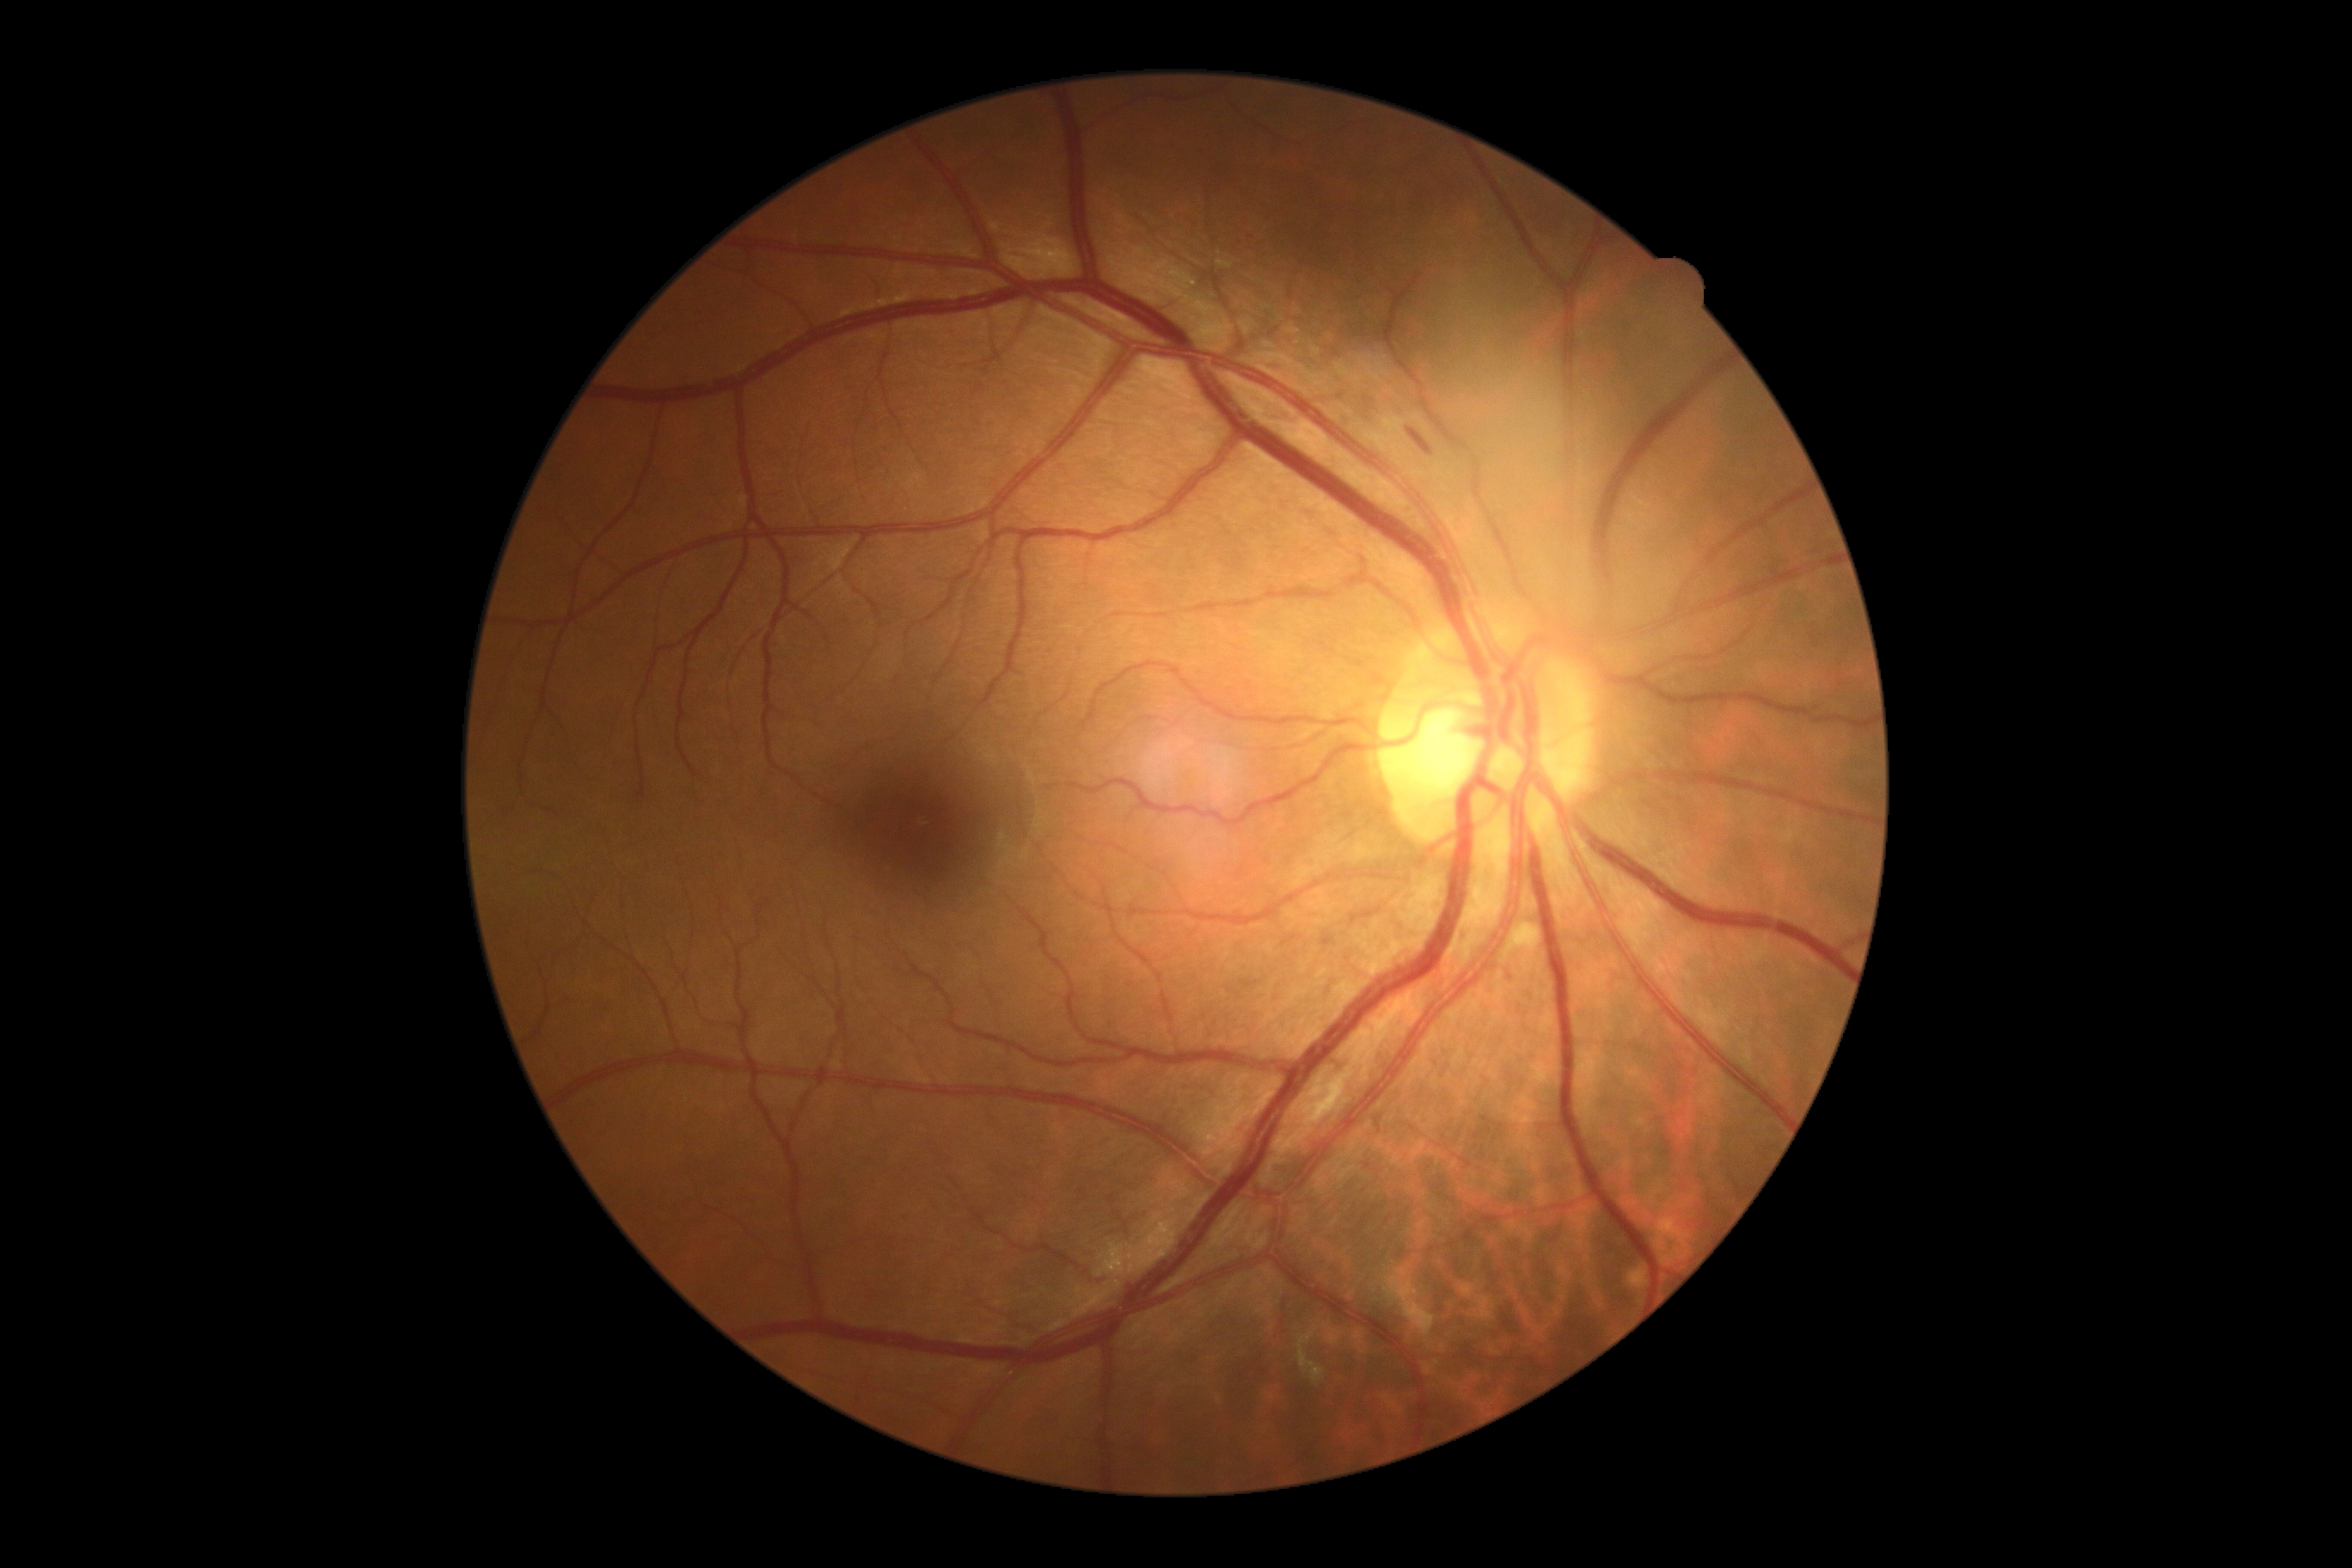 Diabetic retinopathy (DR): grade 2 — more than just microaneurysms but less than severe NPDR.